2352x1568 · fundus photo · 45° FOV — 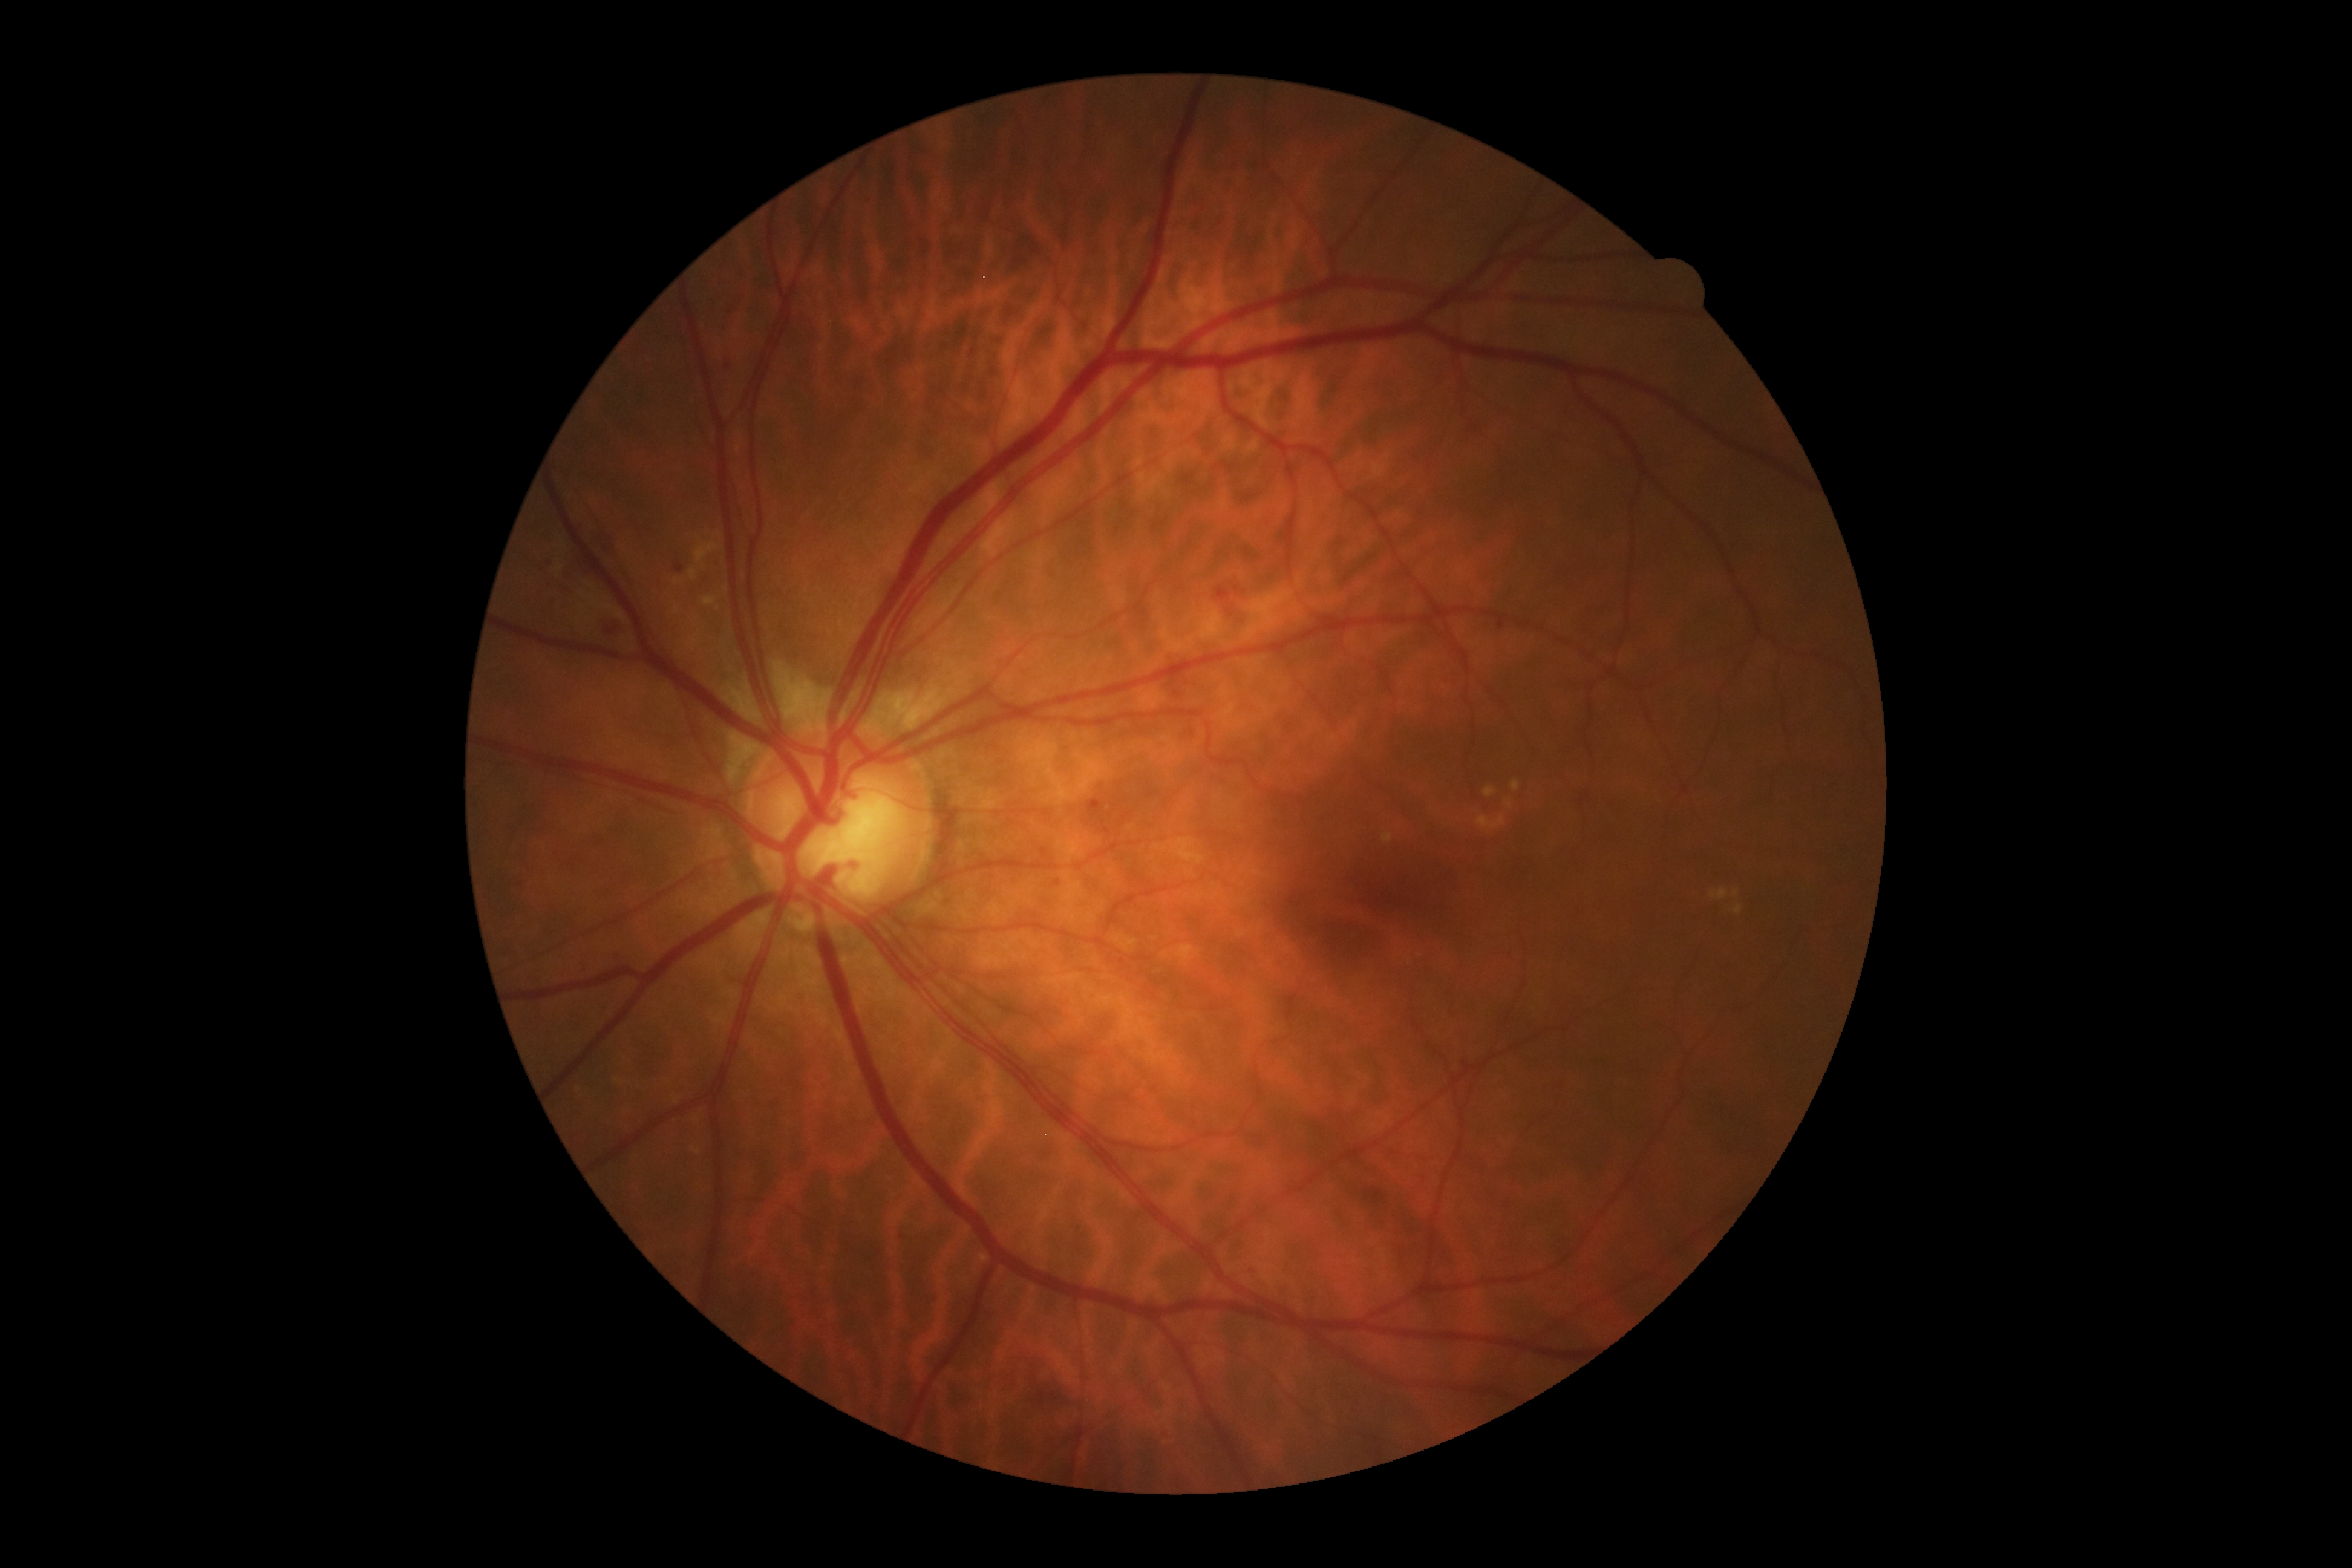
diabetic retinopathy (DR) = grade 2.